Infant wide-field fundus photograph; acquired on the Clarity RetCam 3 — 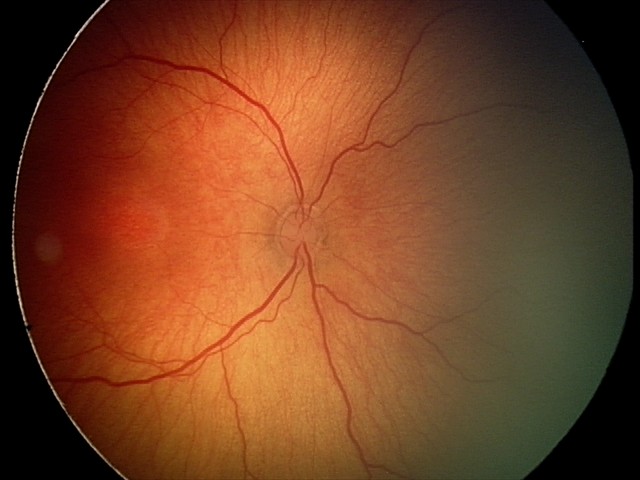

Screening: retinopathy of prematurity stage 2 | no plus disease.